Color fundus photograph: 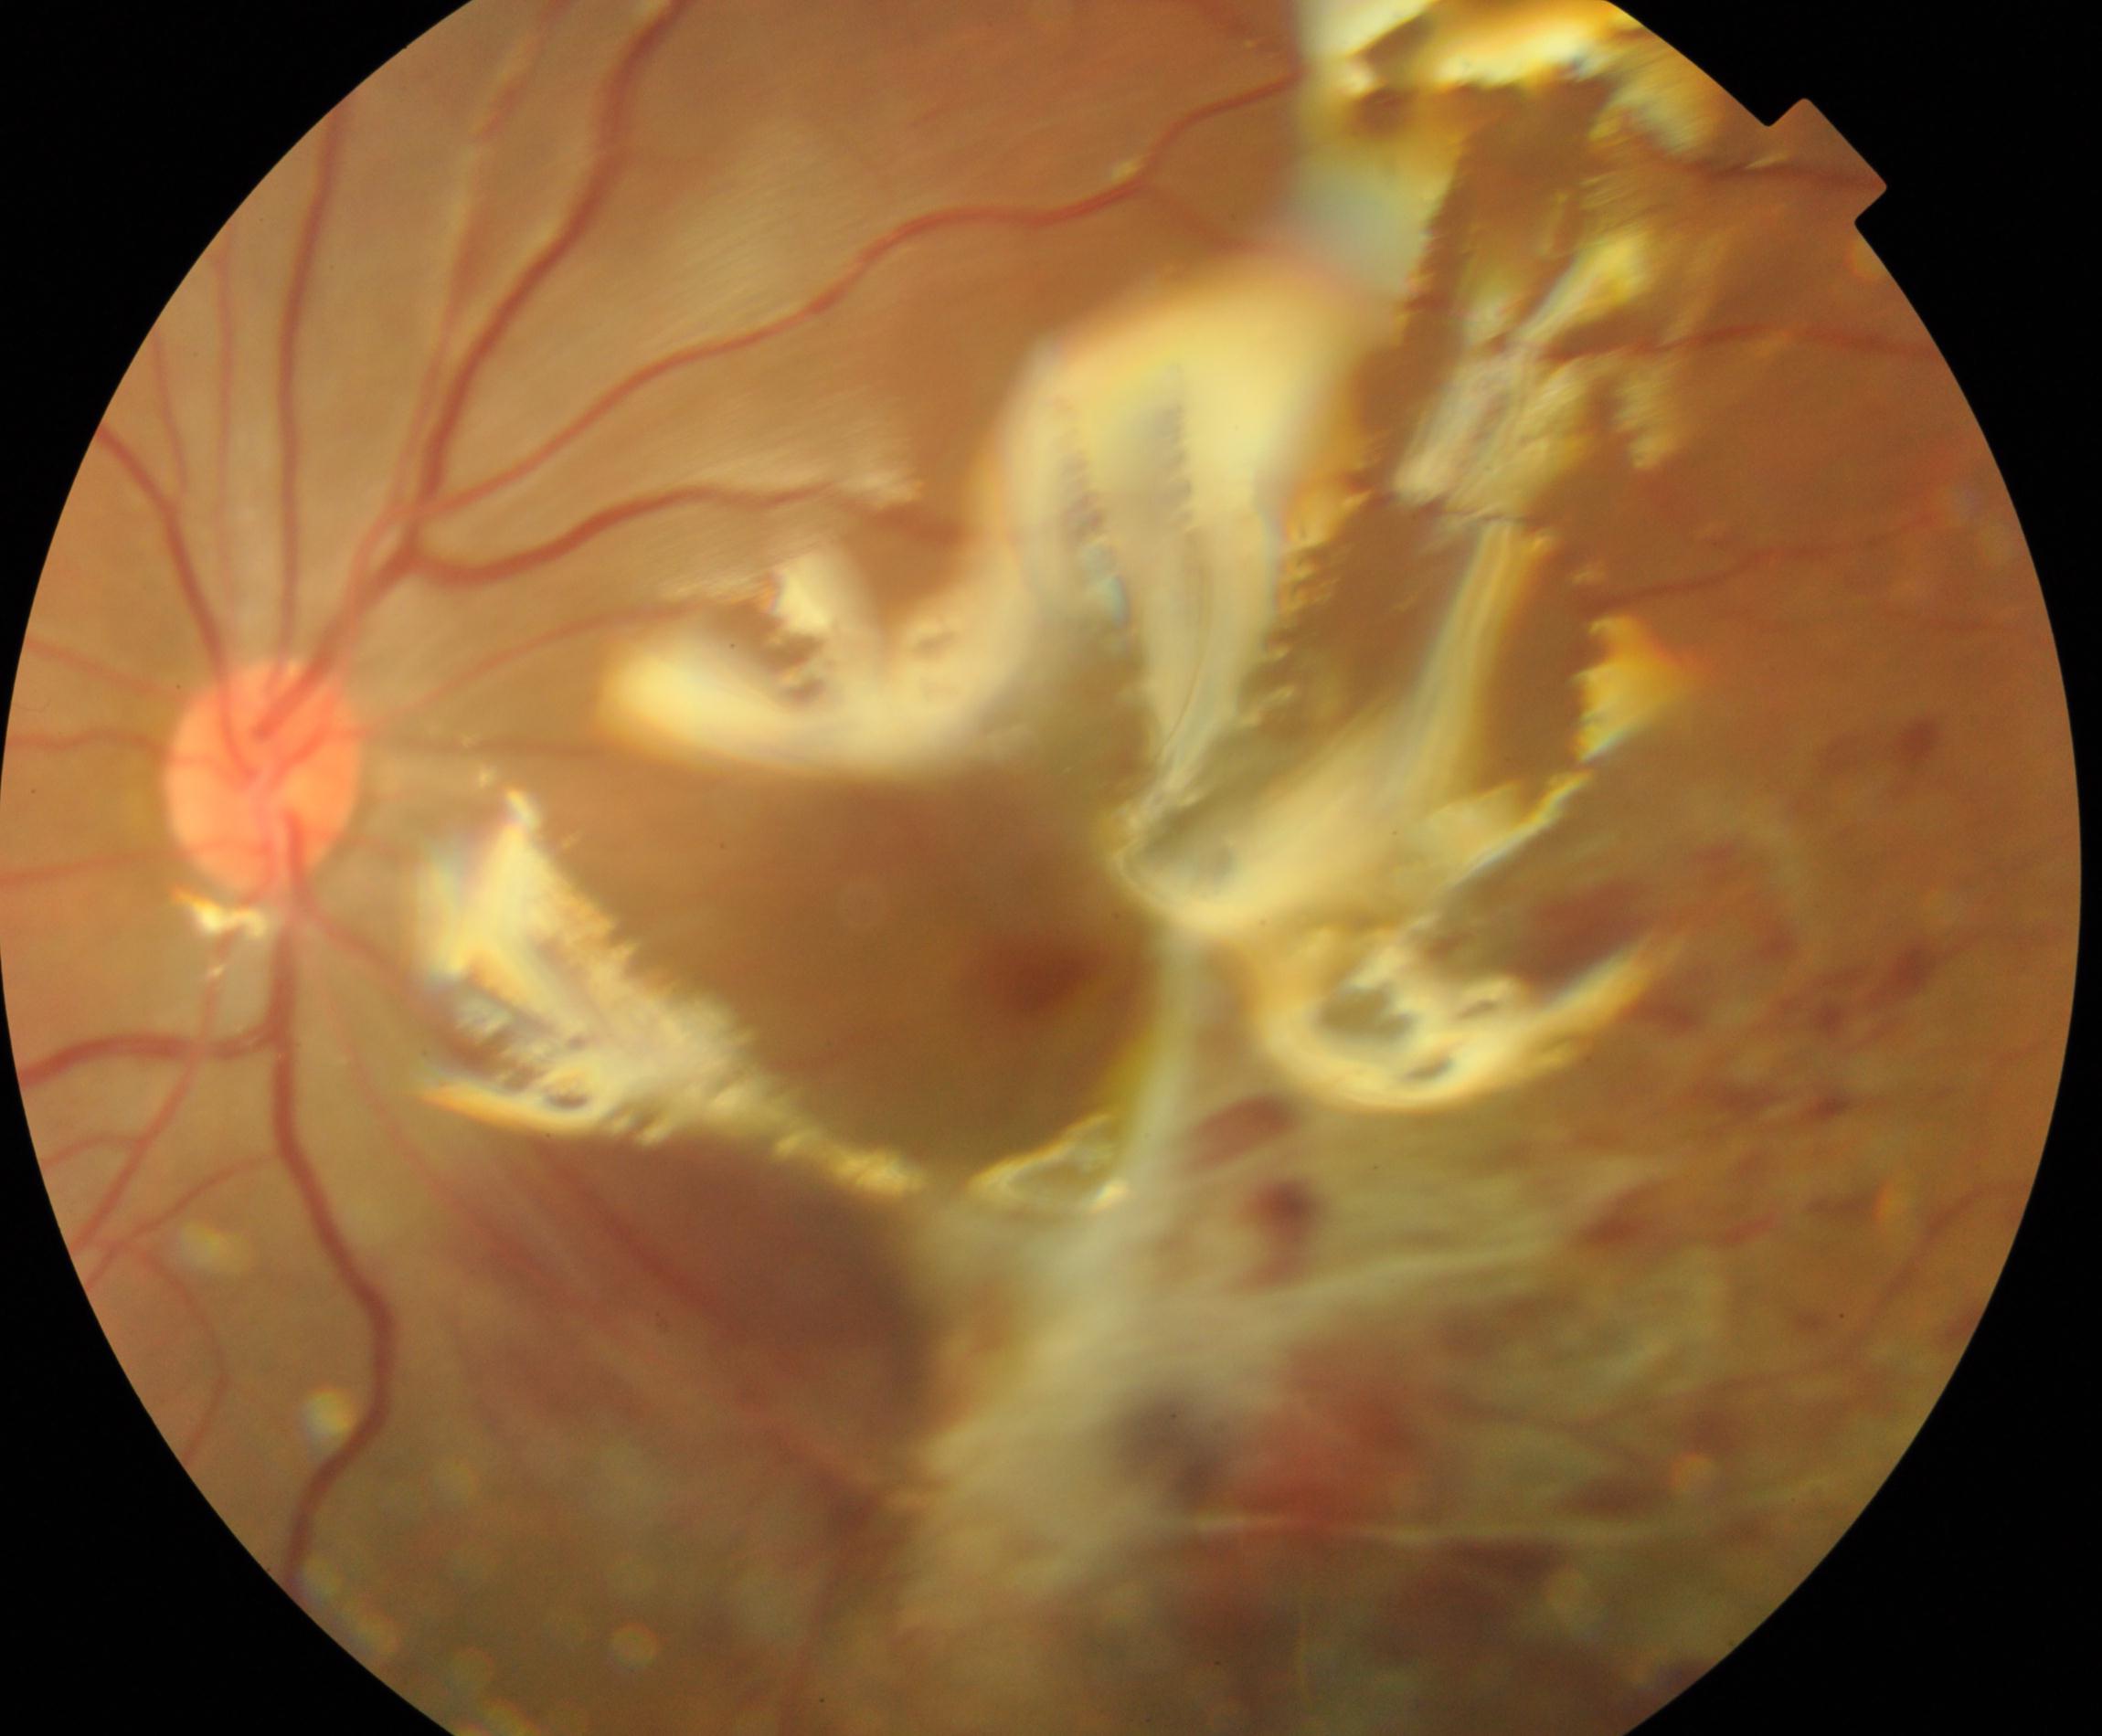
Notable finding: silicone oil in the eye.